Pediatric wide-field fundus photograph. Camera: Clarity RetCam 3 (130° FOV). 640x480px.
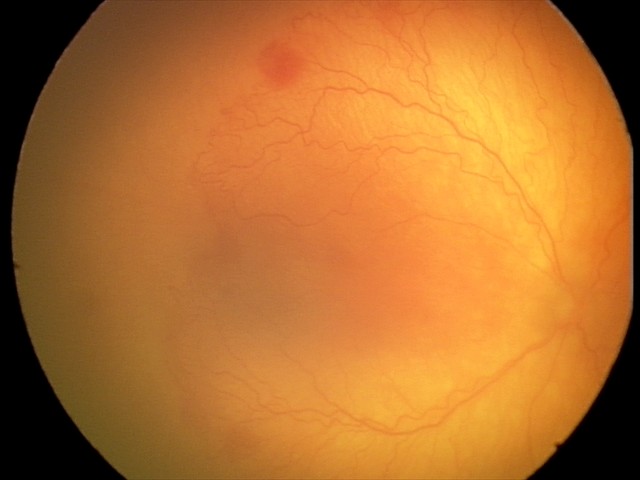

Plus disease was diagnosed.
Series diagnosed as aggressive ROP (A-ROP).